Color fundus image.
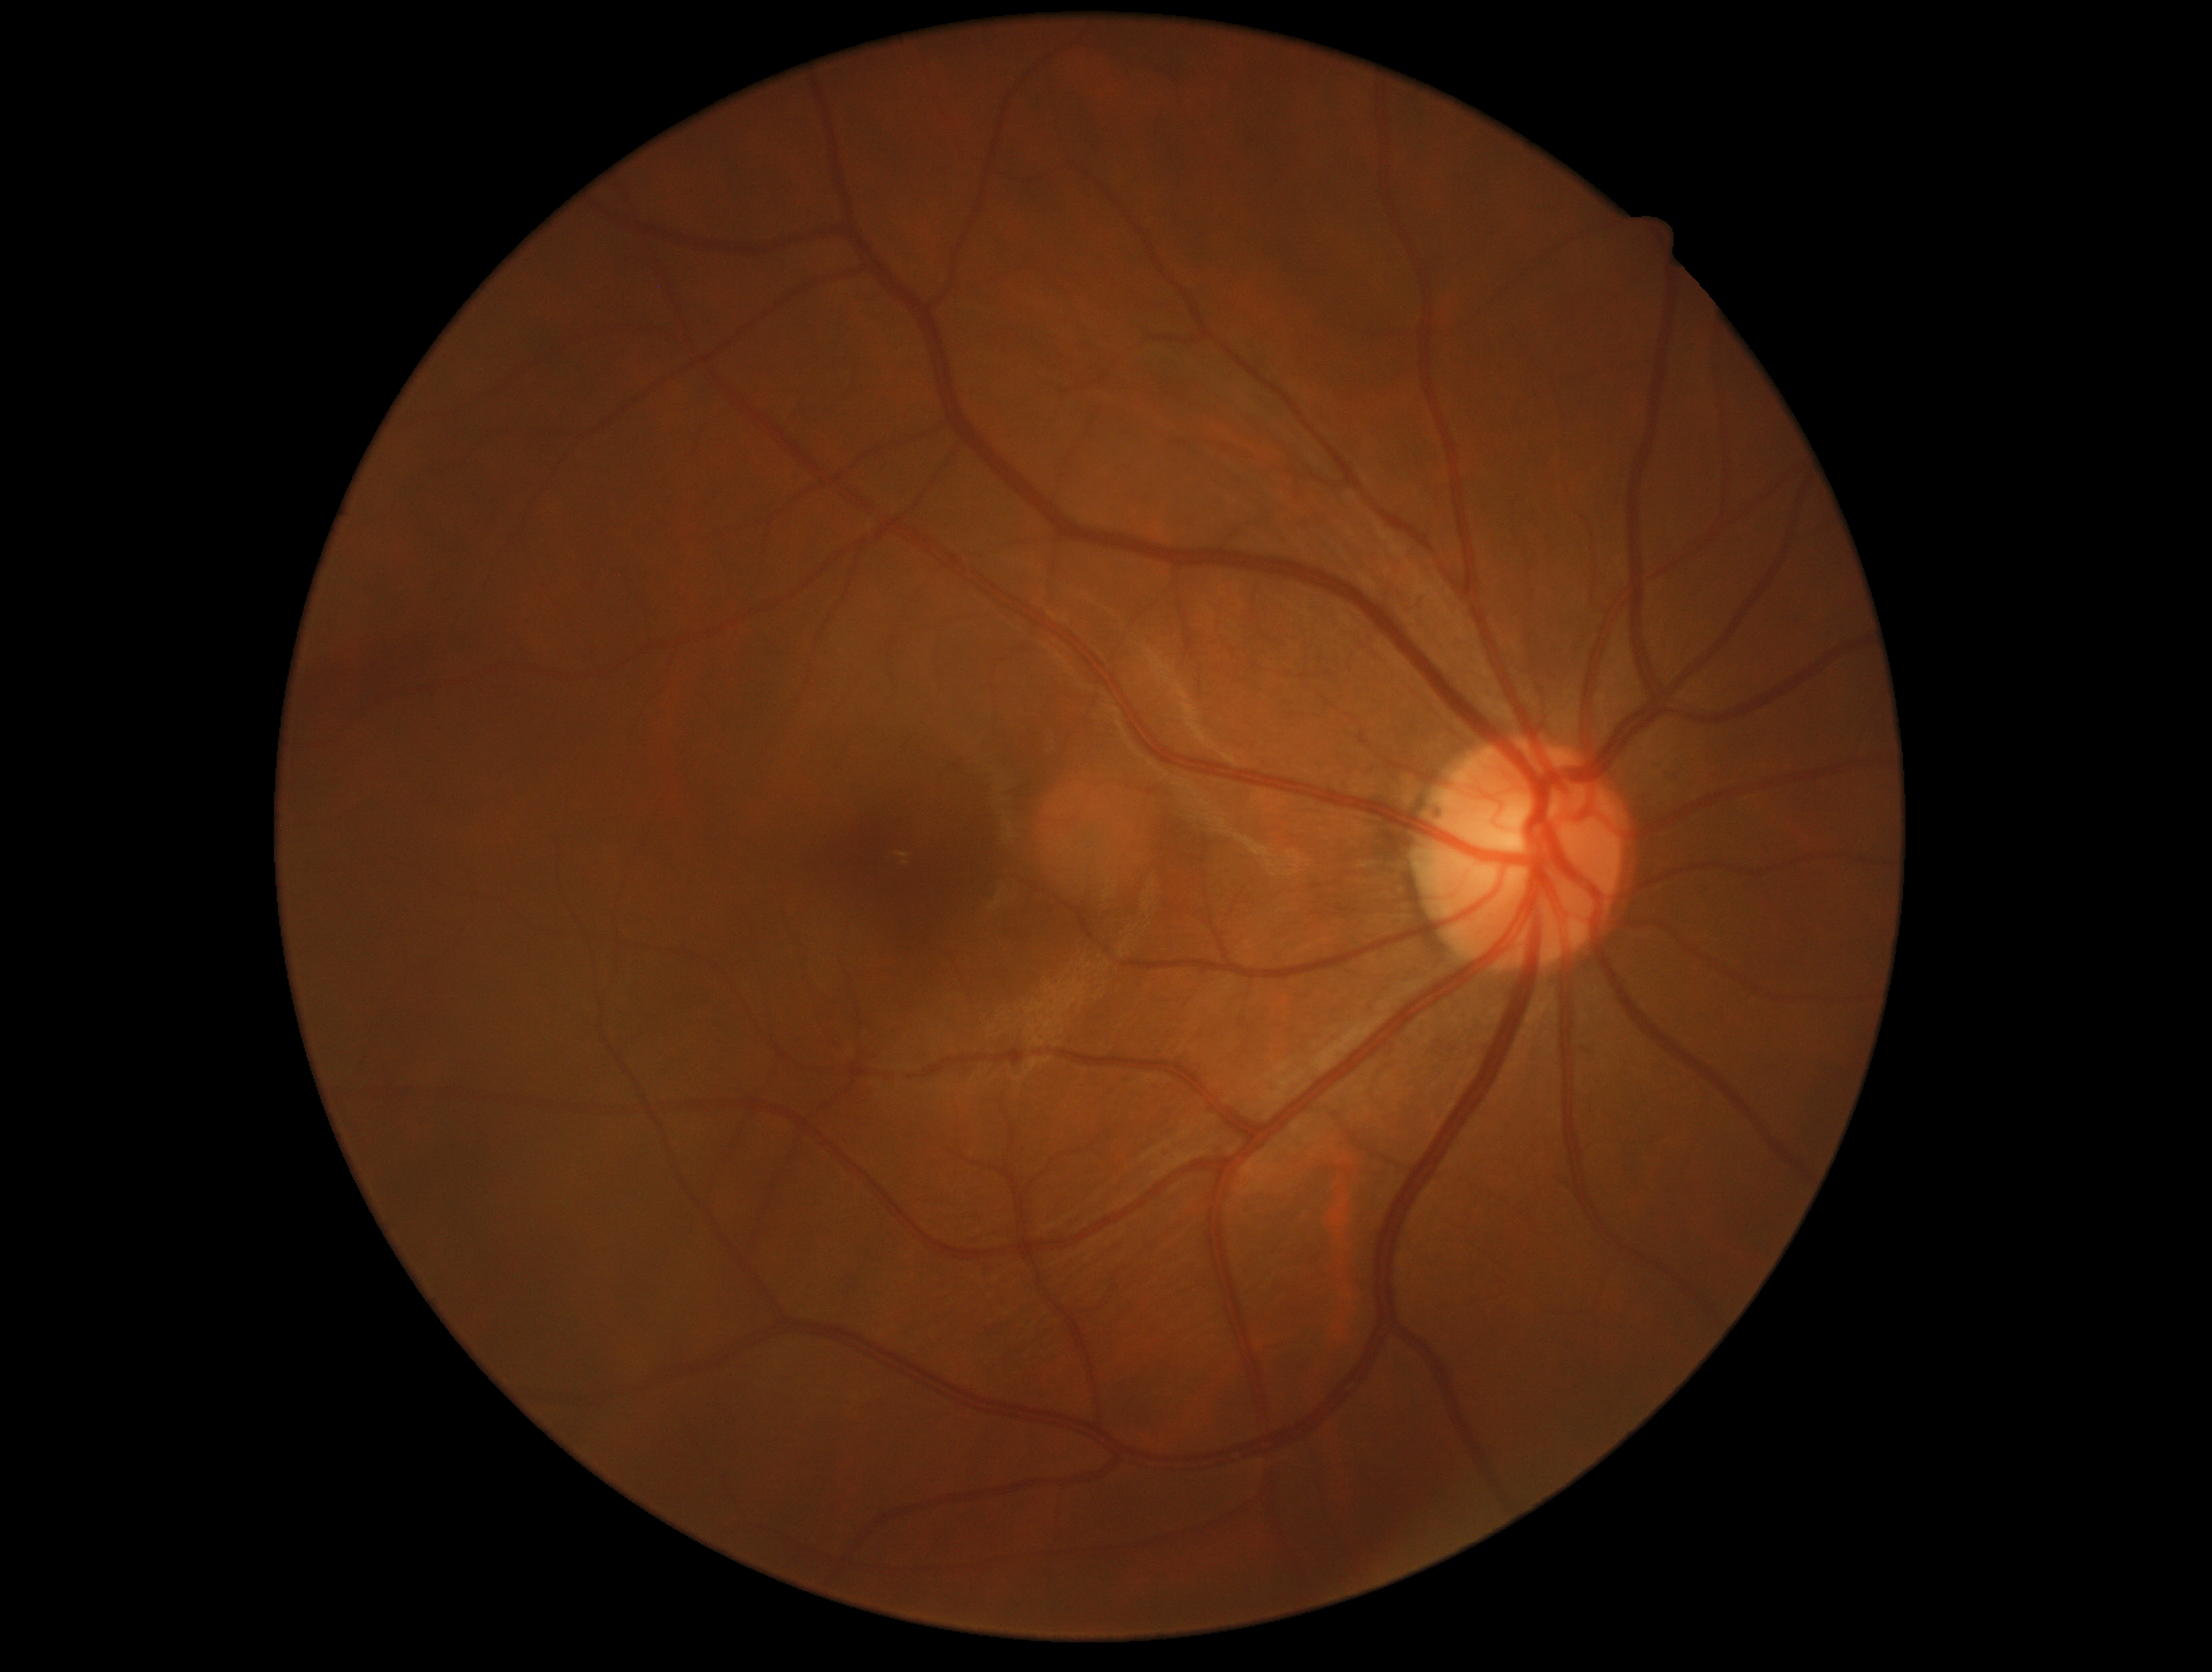

DR severity is no apparent diabetic retinopathy (grade 0).
No DR findings.